Retinal fundus photograph
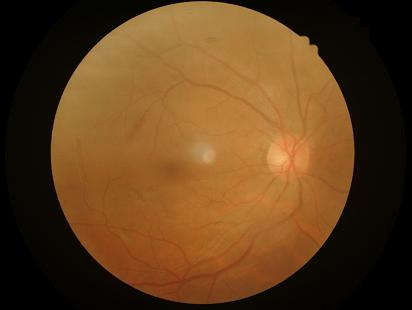

{"clarity": "sharp", "overall_quality": "satisfactory", "illumination": "adequate"}